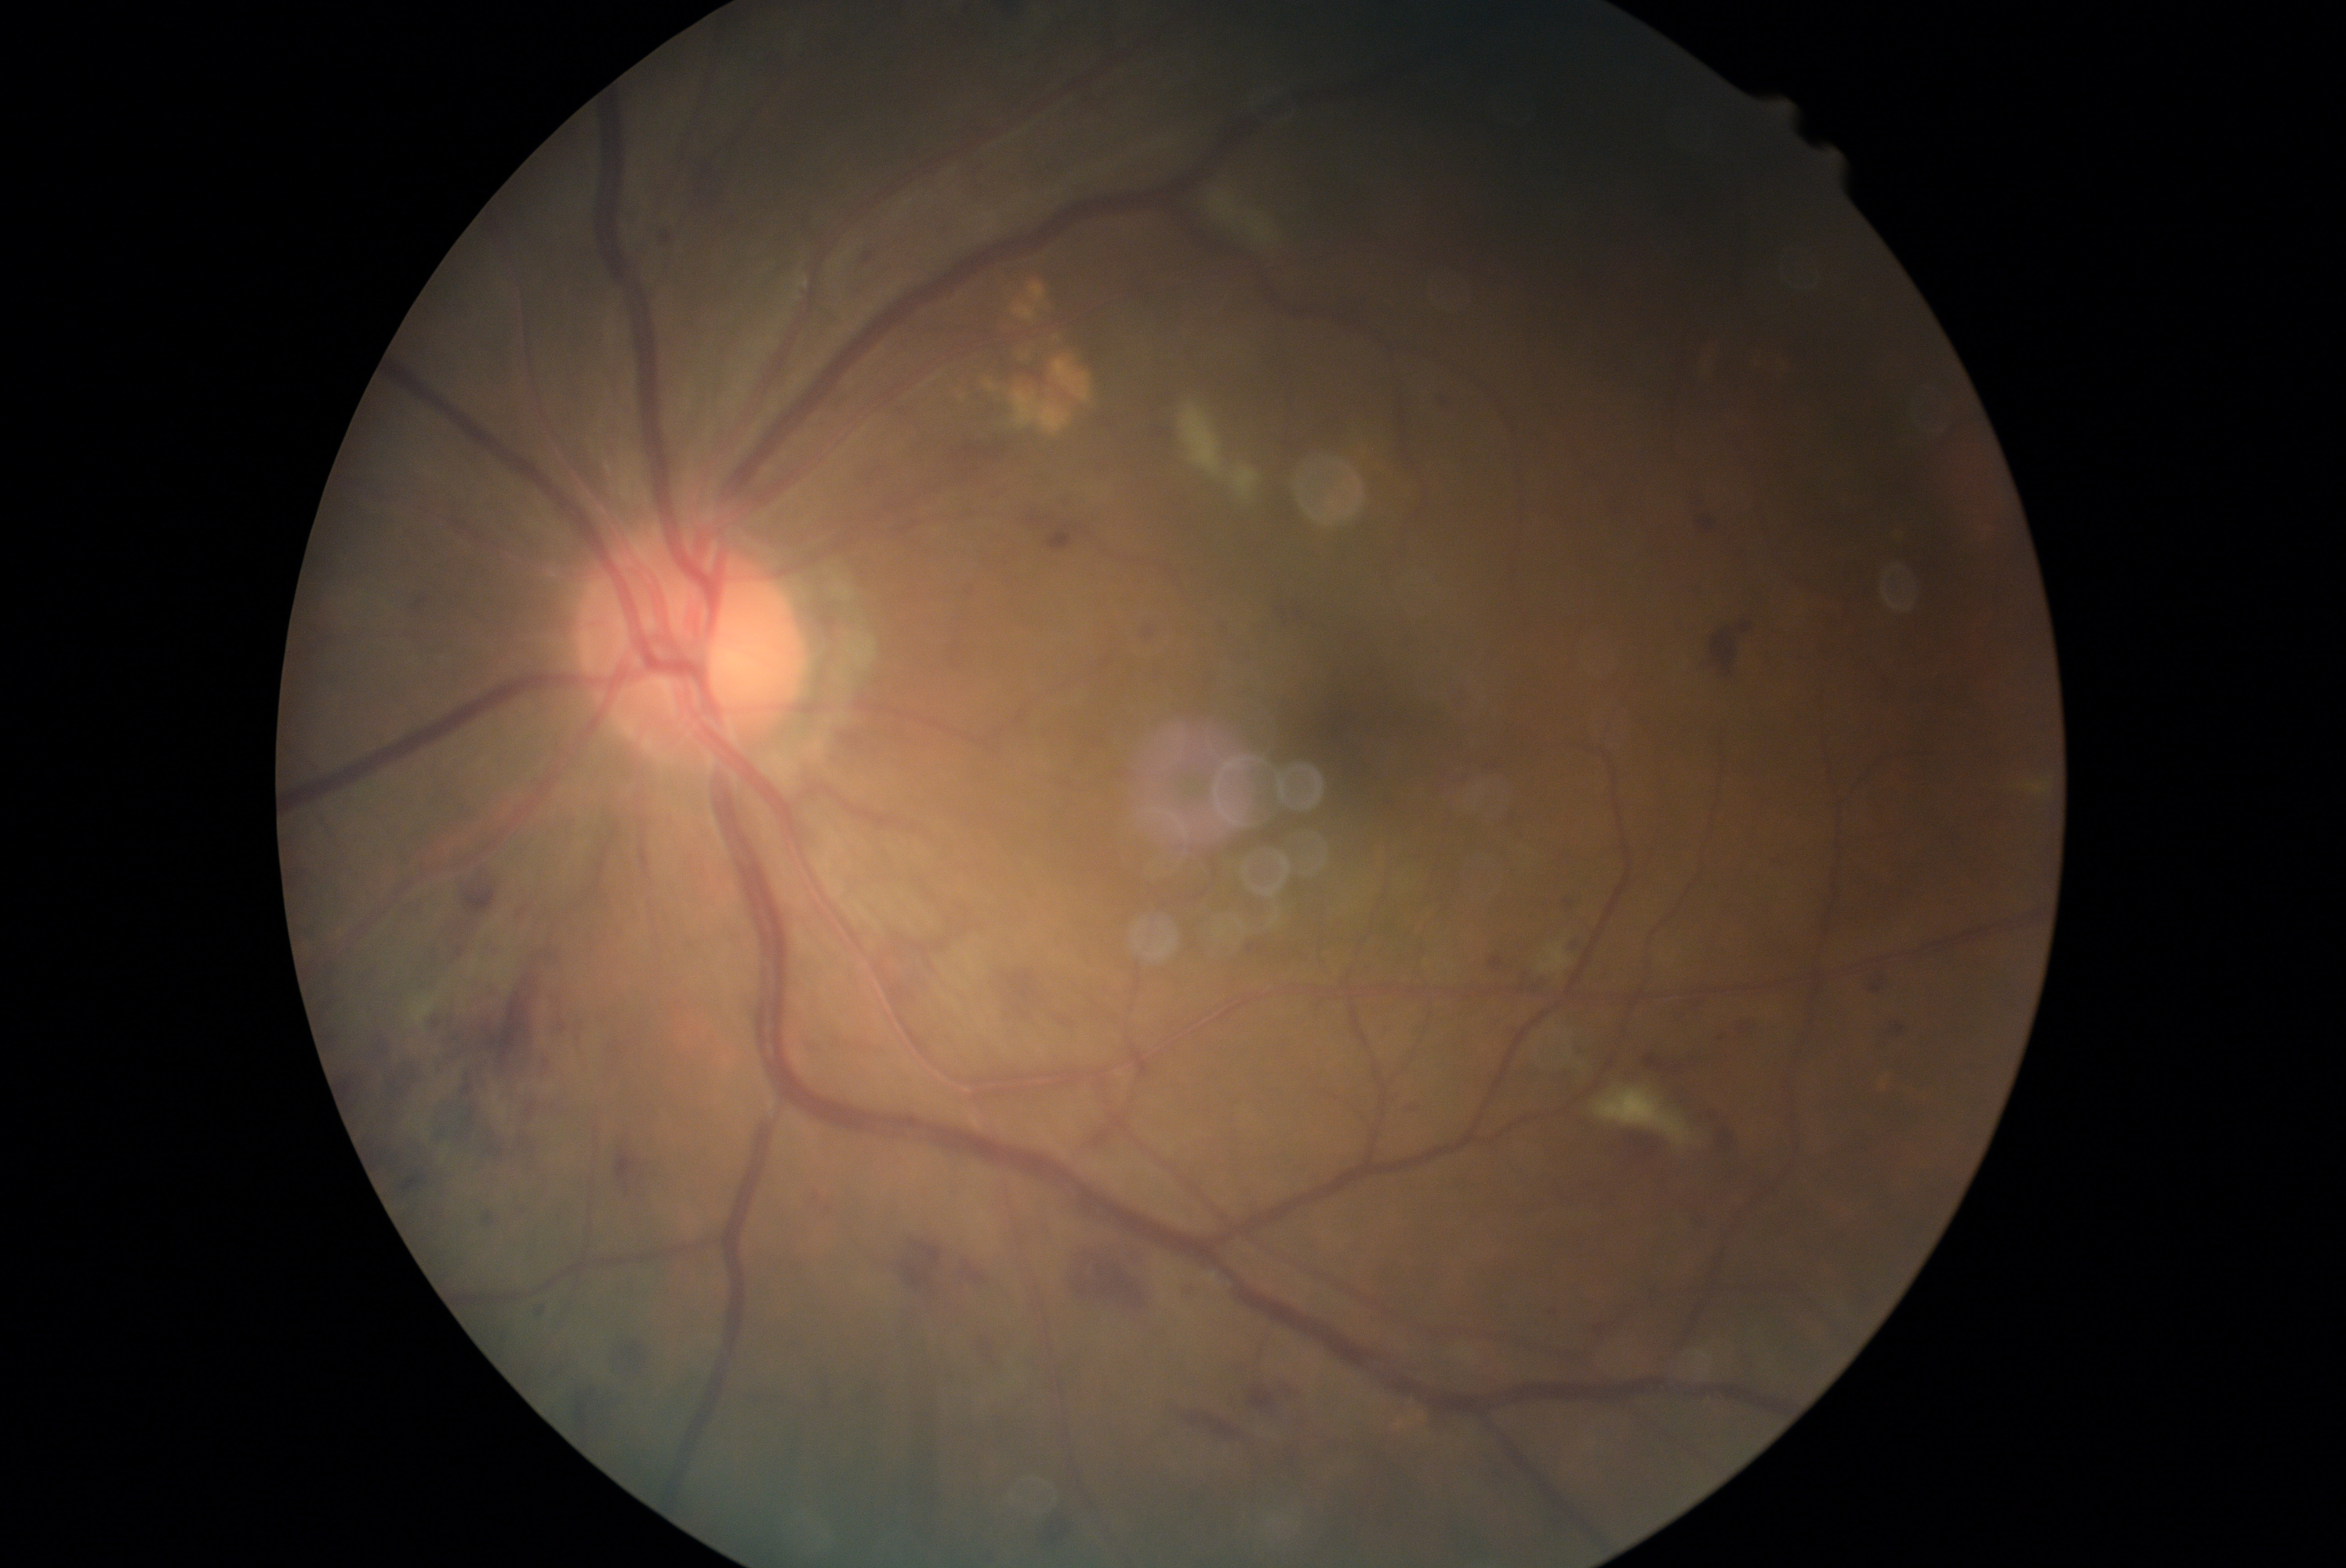

DR stage: moderate NPDR (grade 2). The retinopathy is classified as non-proliferative diabetic retinopathy.